Image size 1240x1240 · acquired on the Phoenix ICON · infant wide-field fundus photograph:
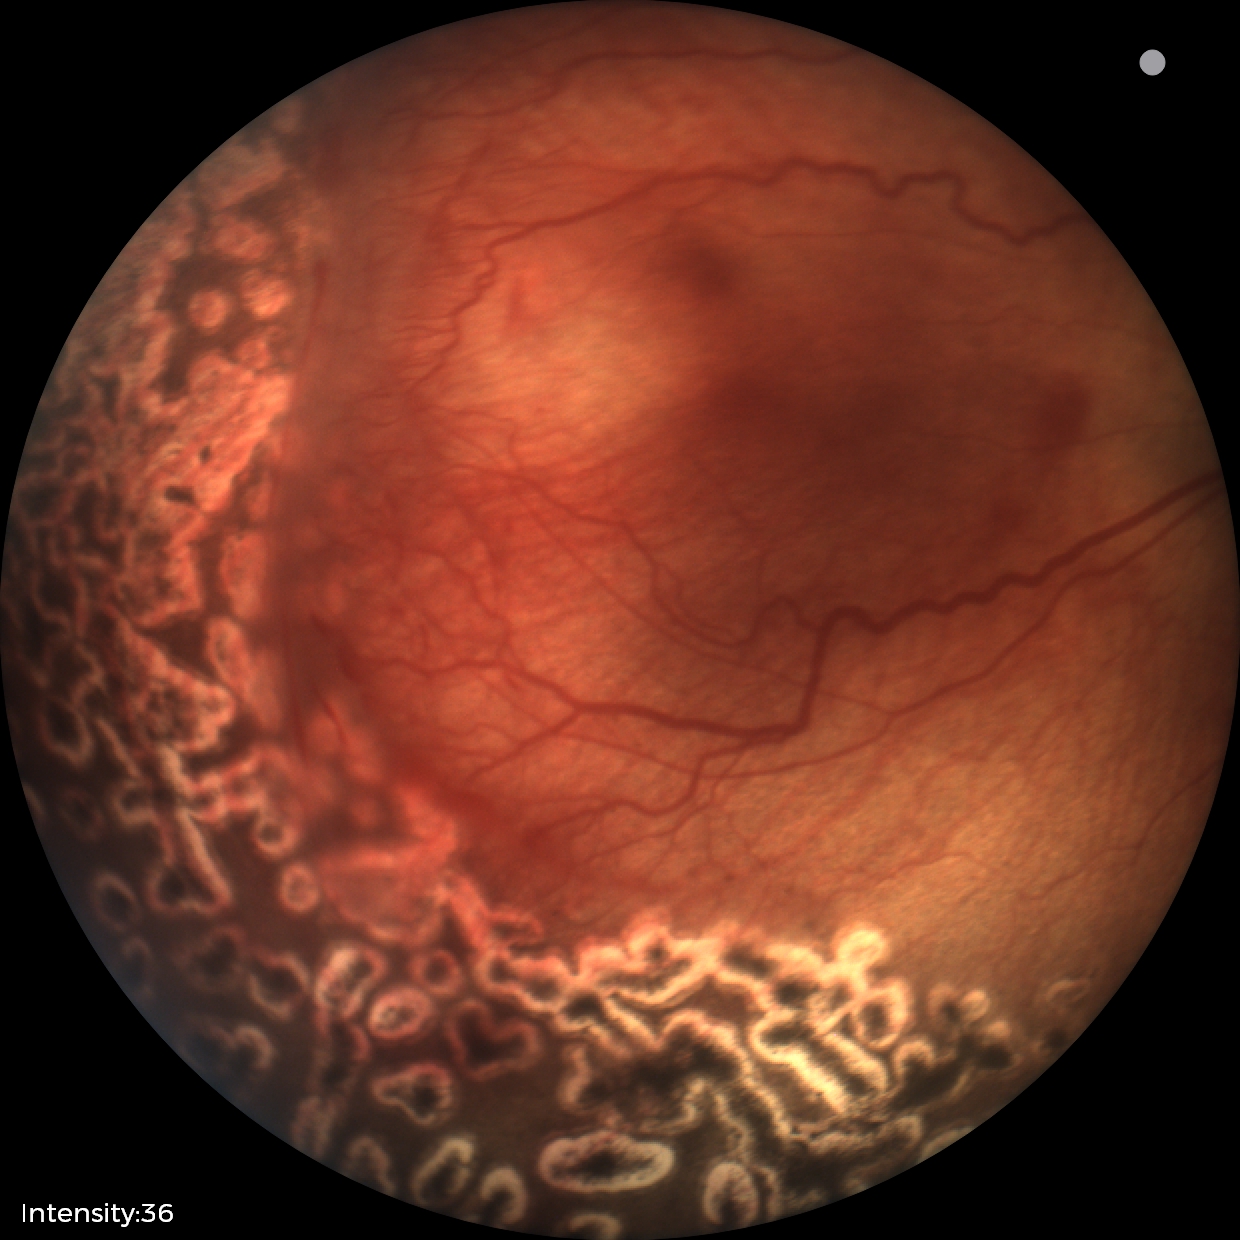
Series diagnosed as status post retinopathy of prematurity.